Image size 2228x1652.
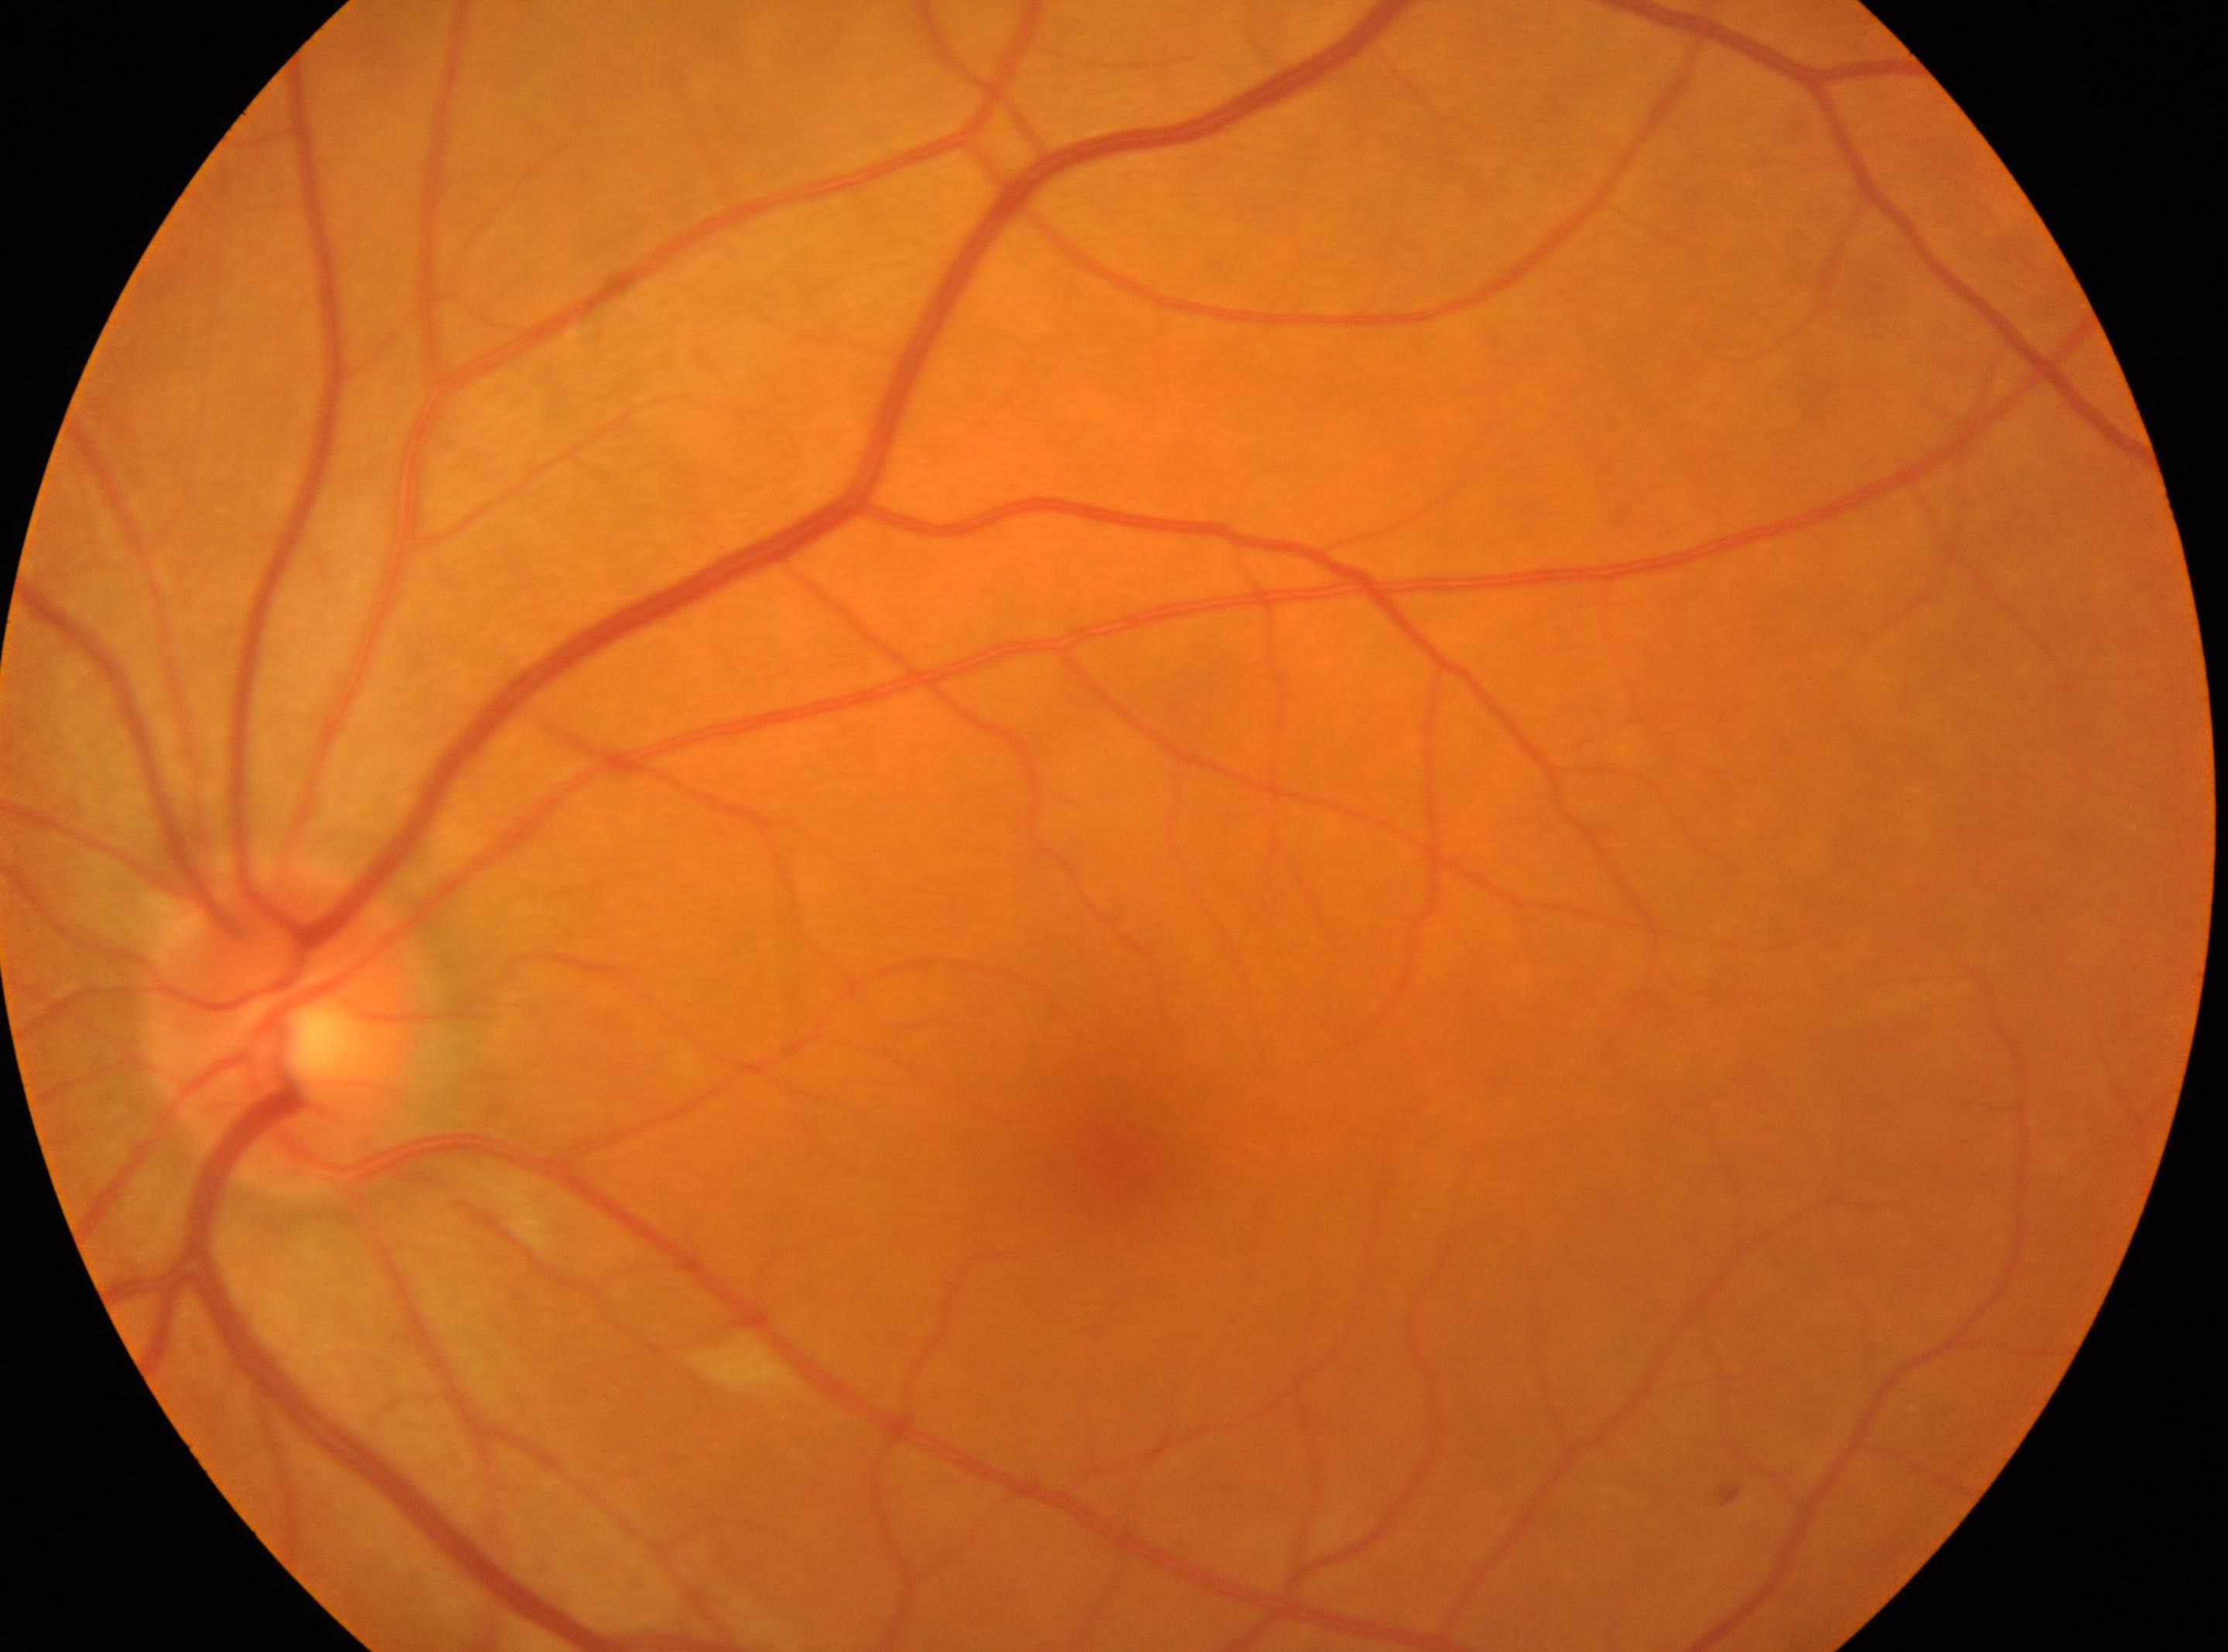 No diabetic retinopathy identified.
Fovea centralis located at (1102,1148).
Optic disk: (289,1029).
The image shows the OS.
DR is grade 0.